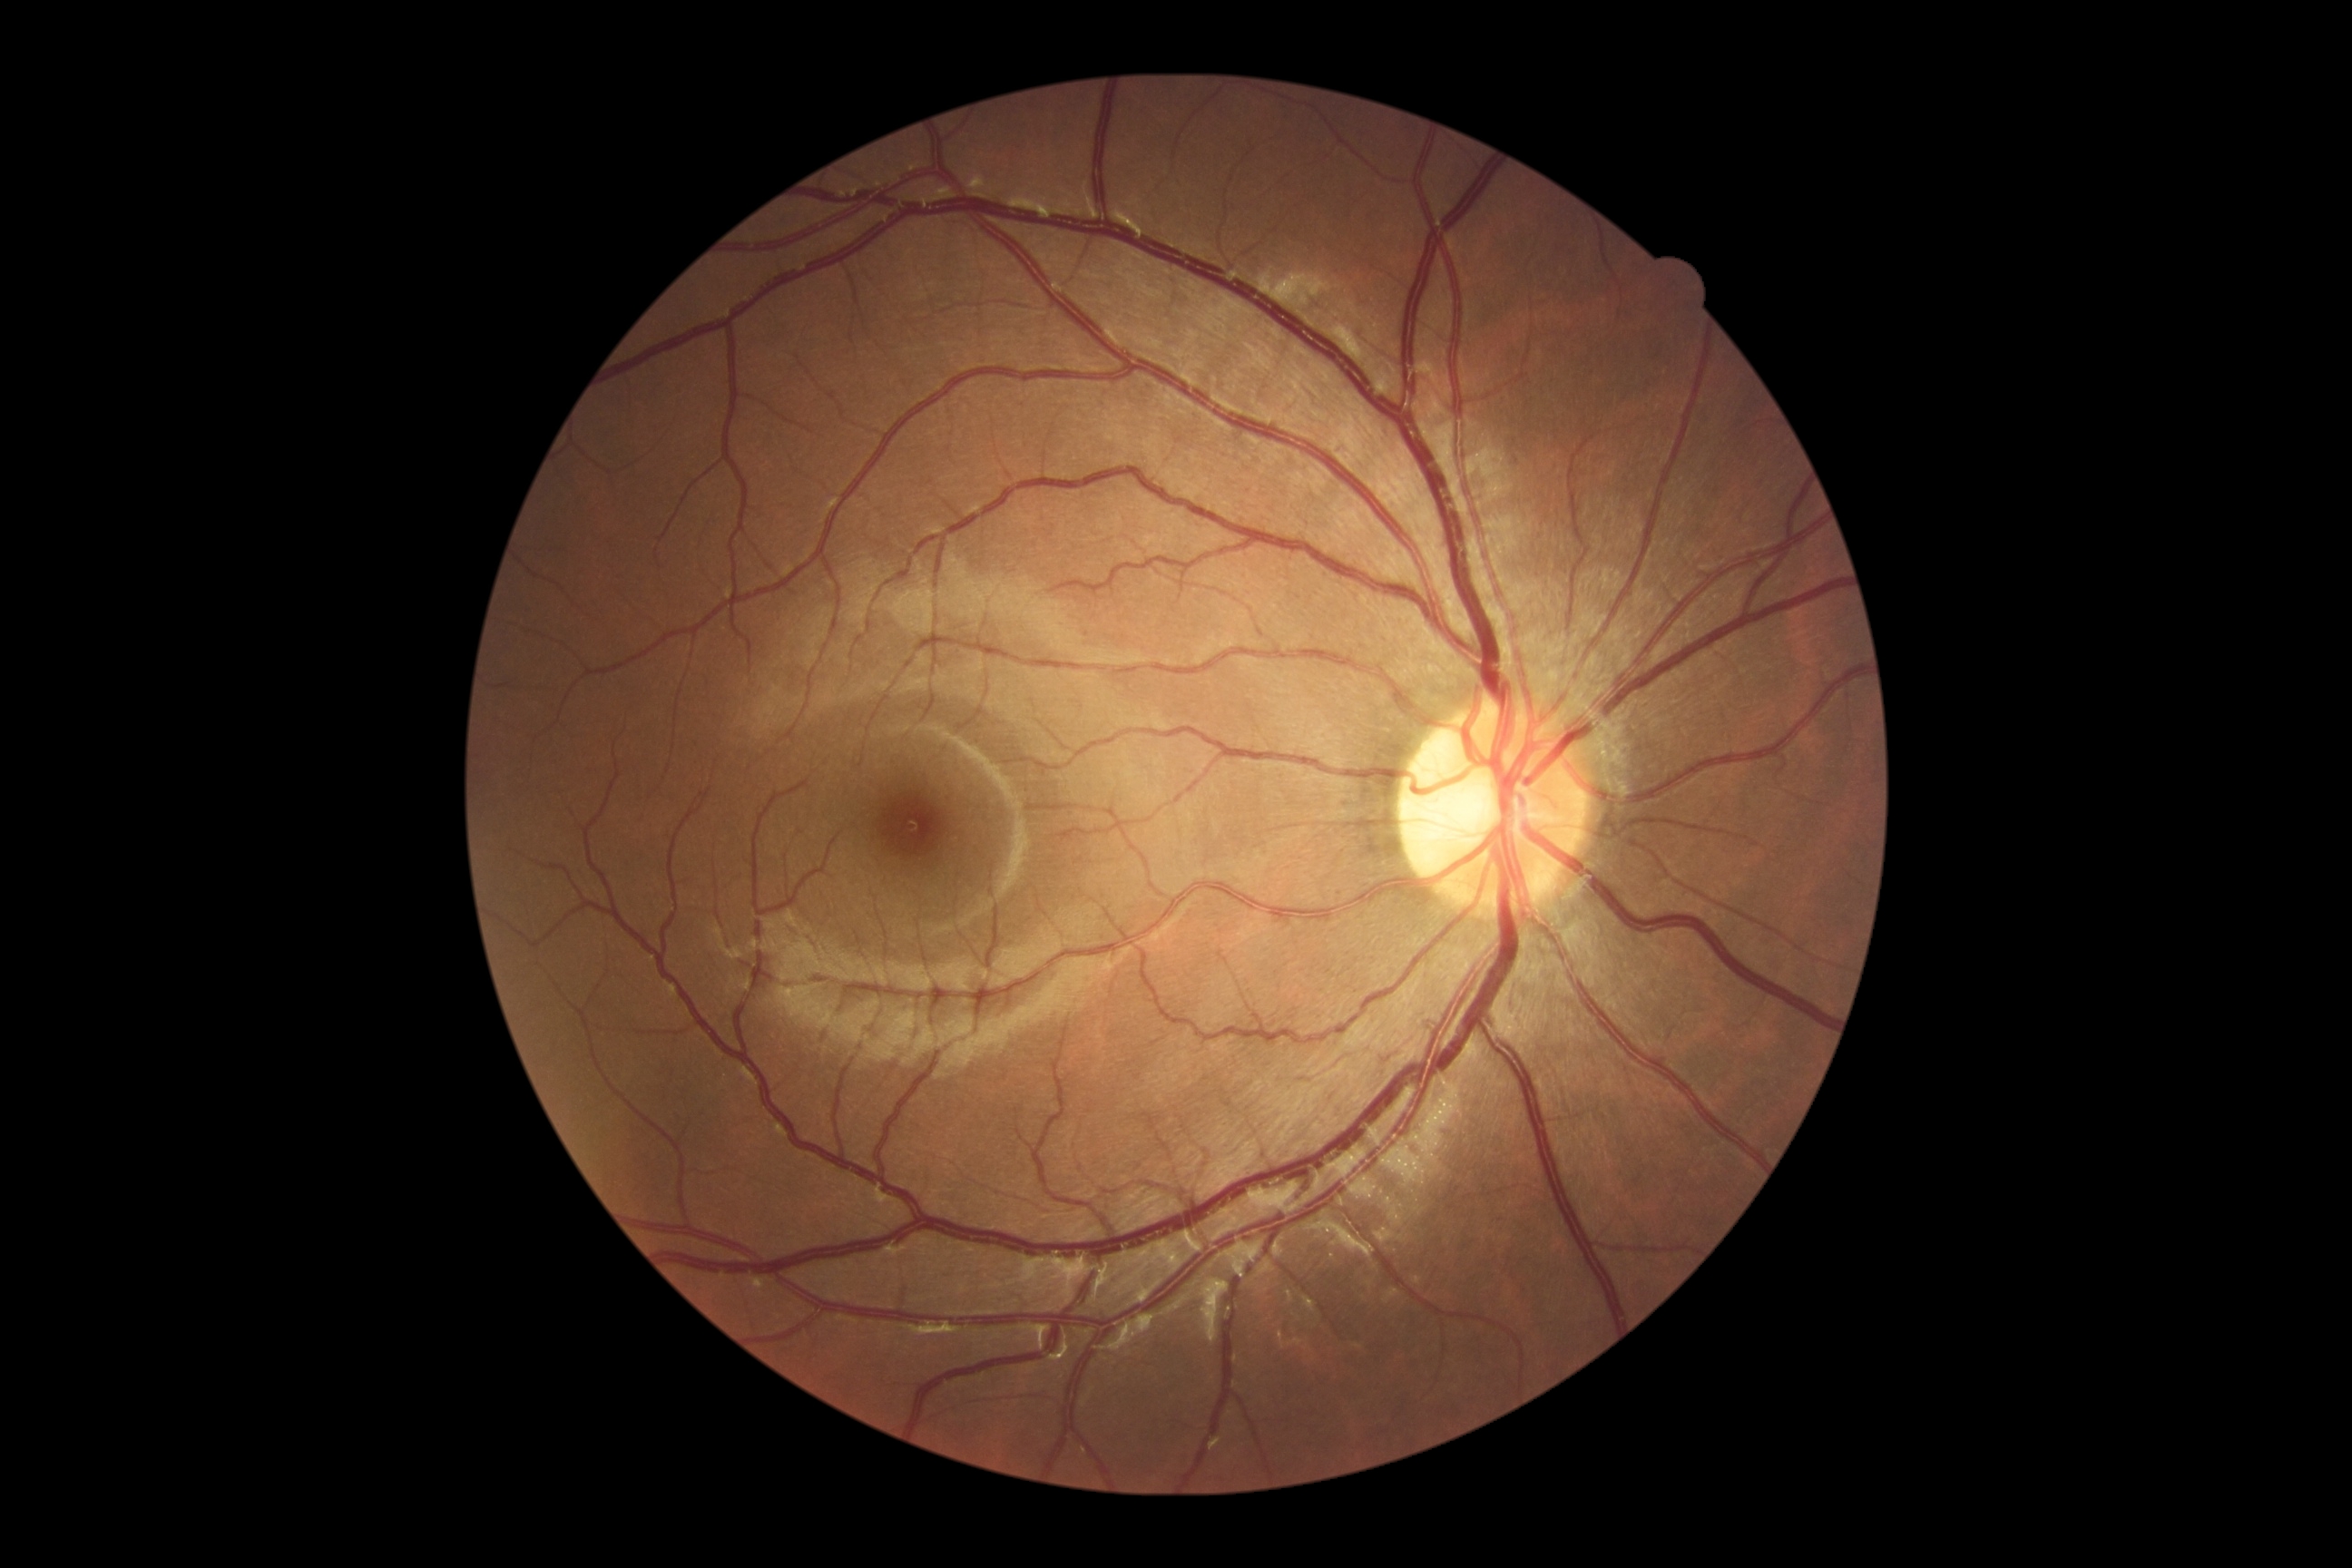

- diabetic retinopathy (DR) — 0